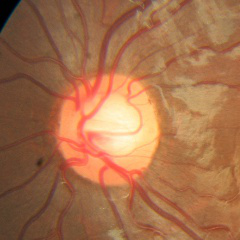

Fundus appearance consistent with no signs of glaucoma.